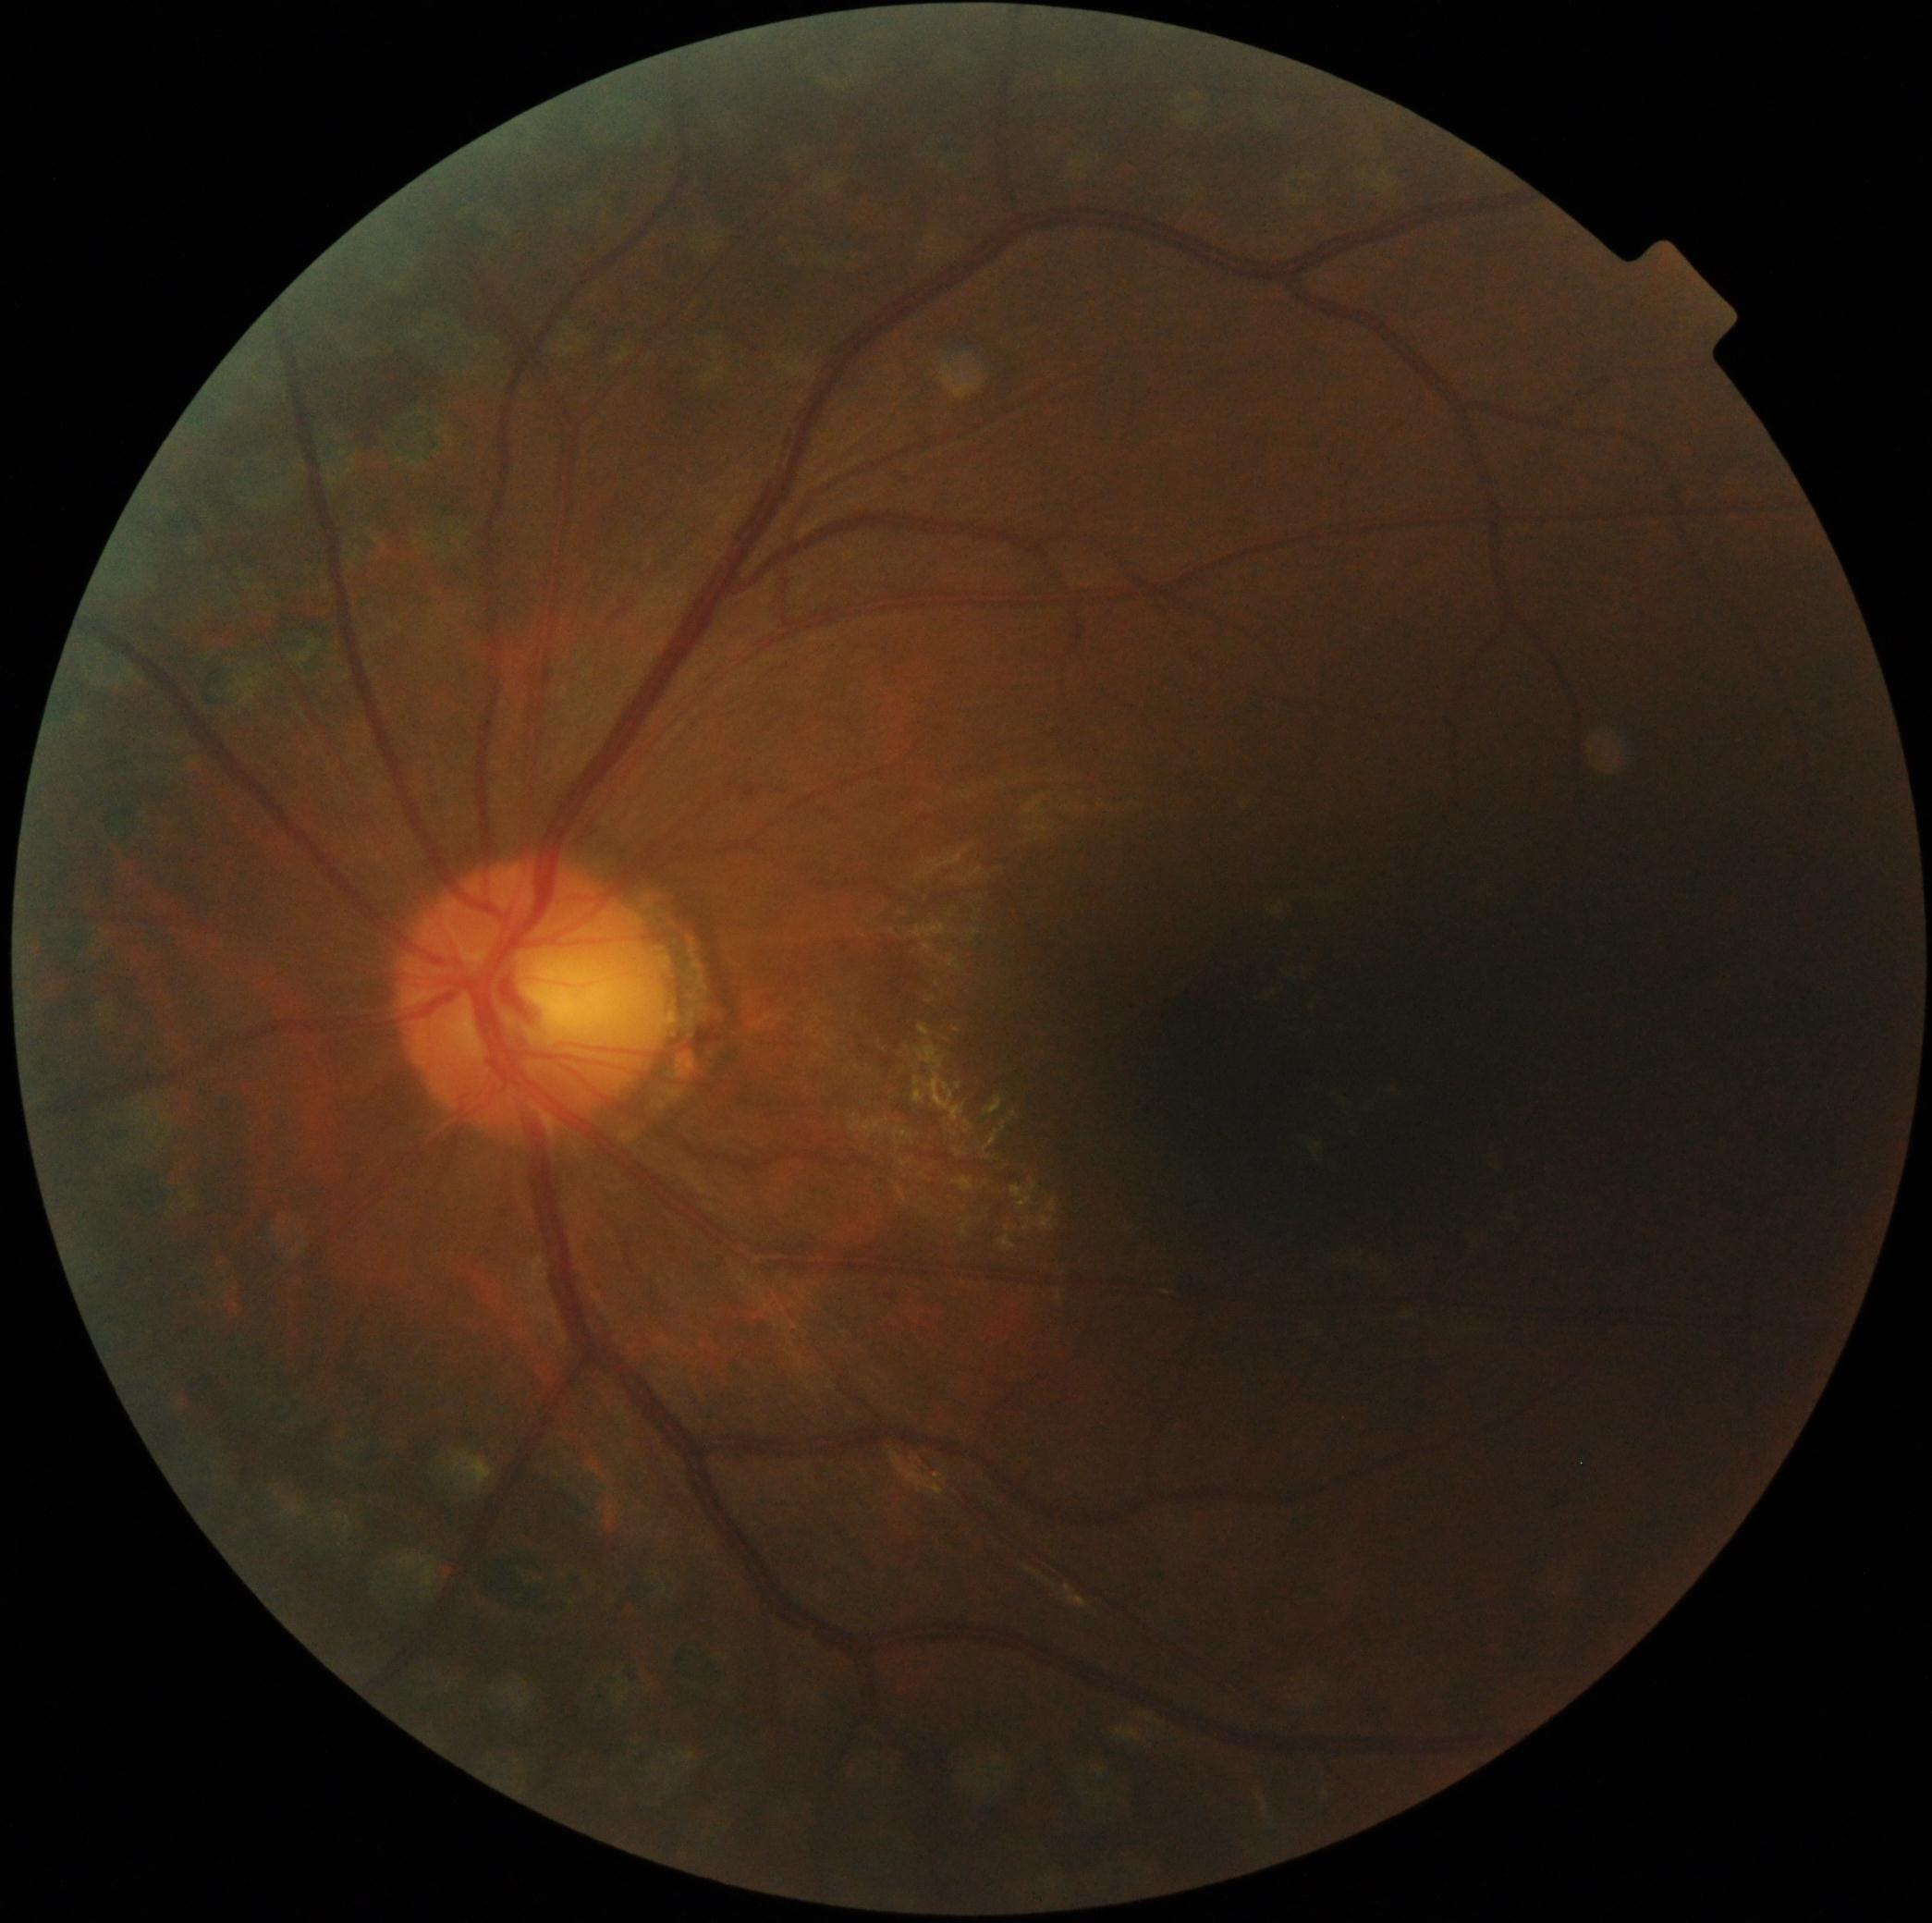

Diabetic retinopathy: grade 1.